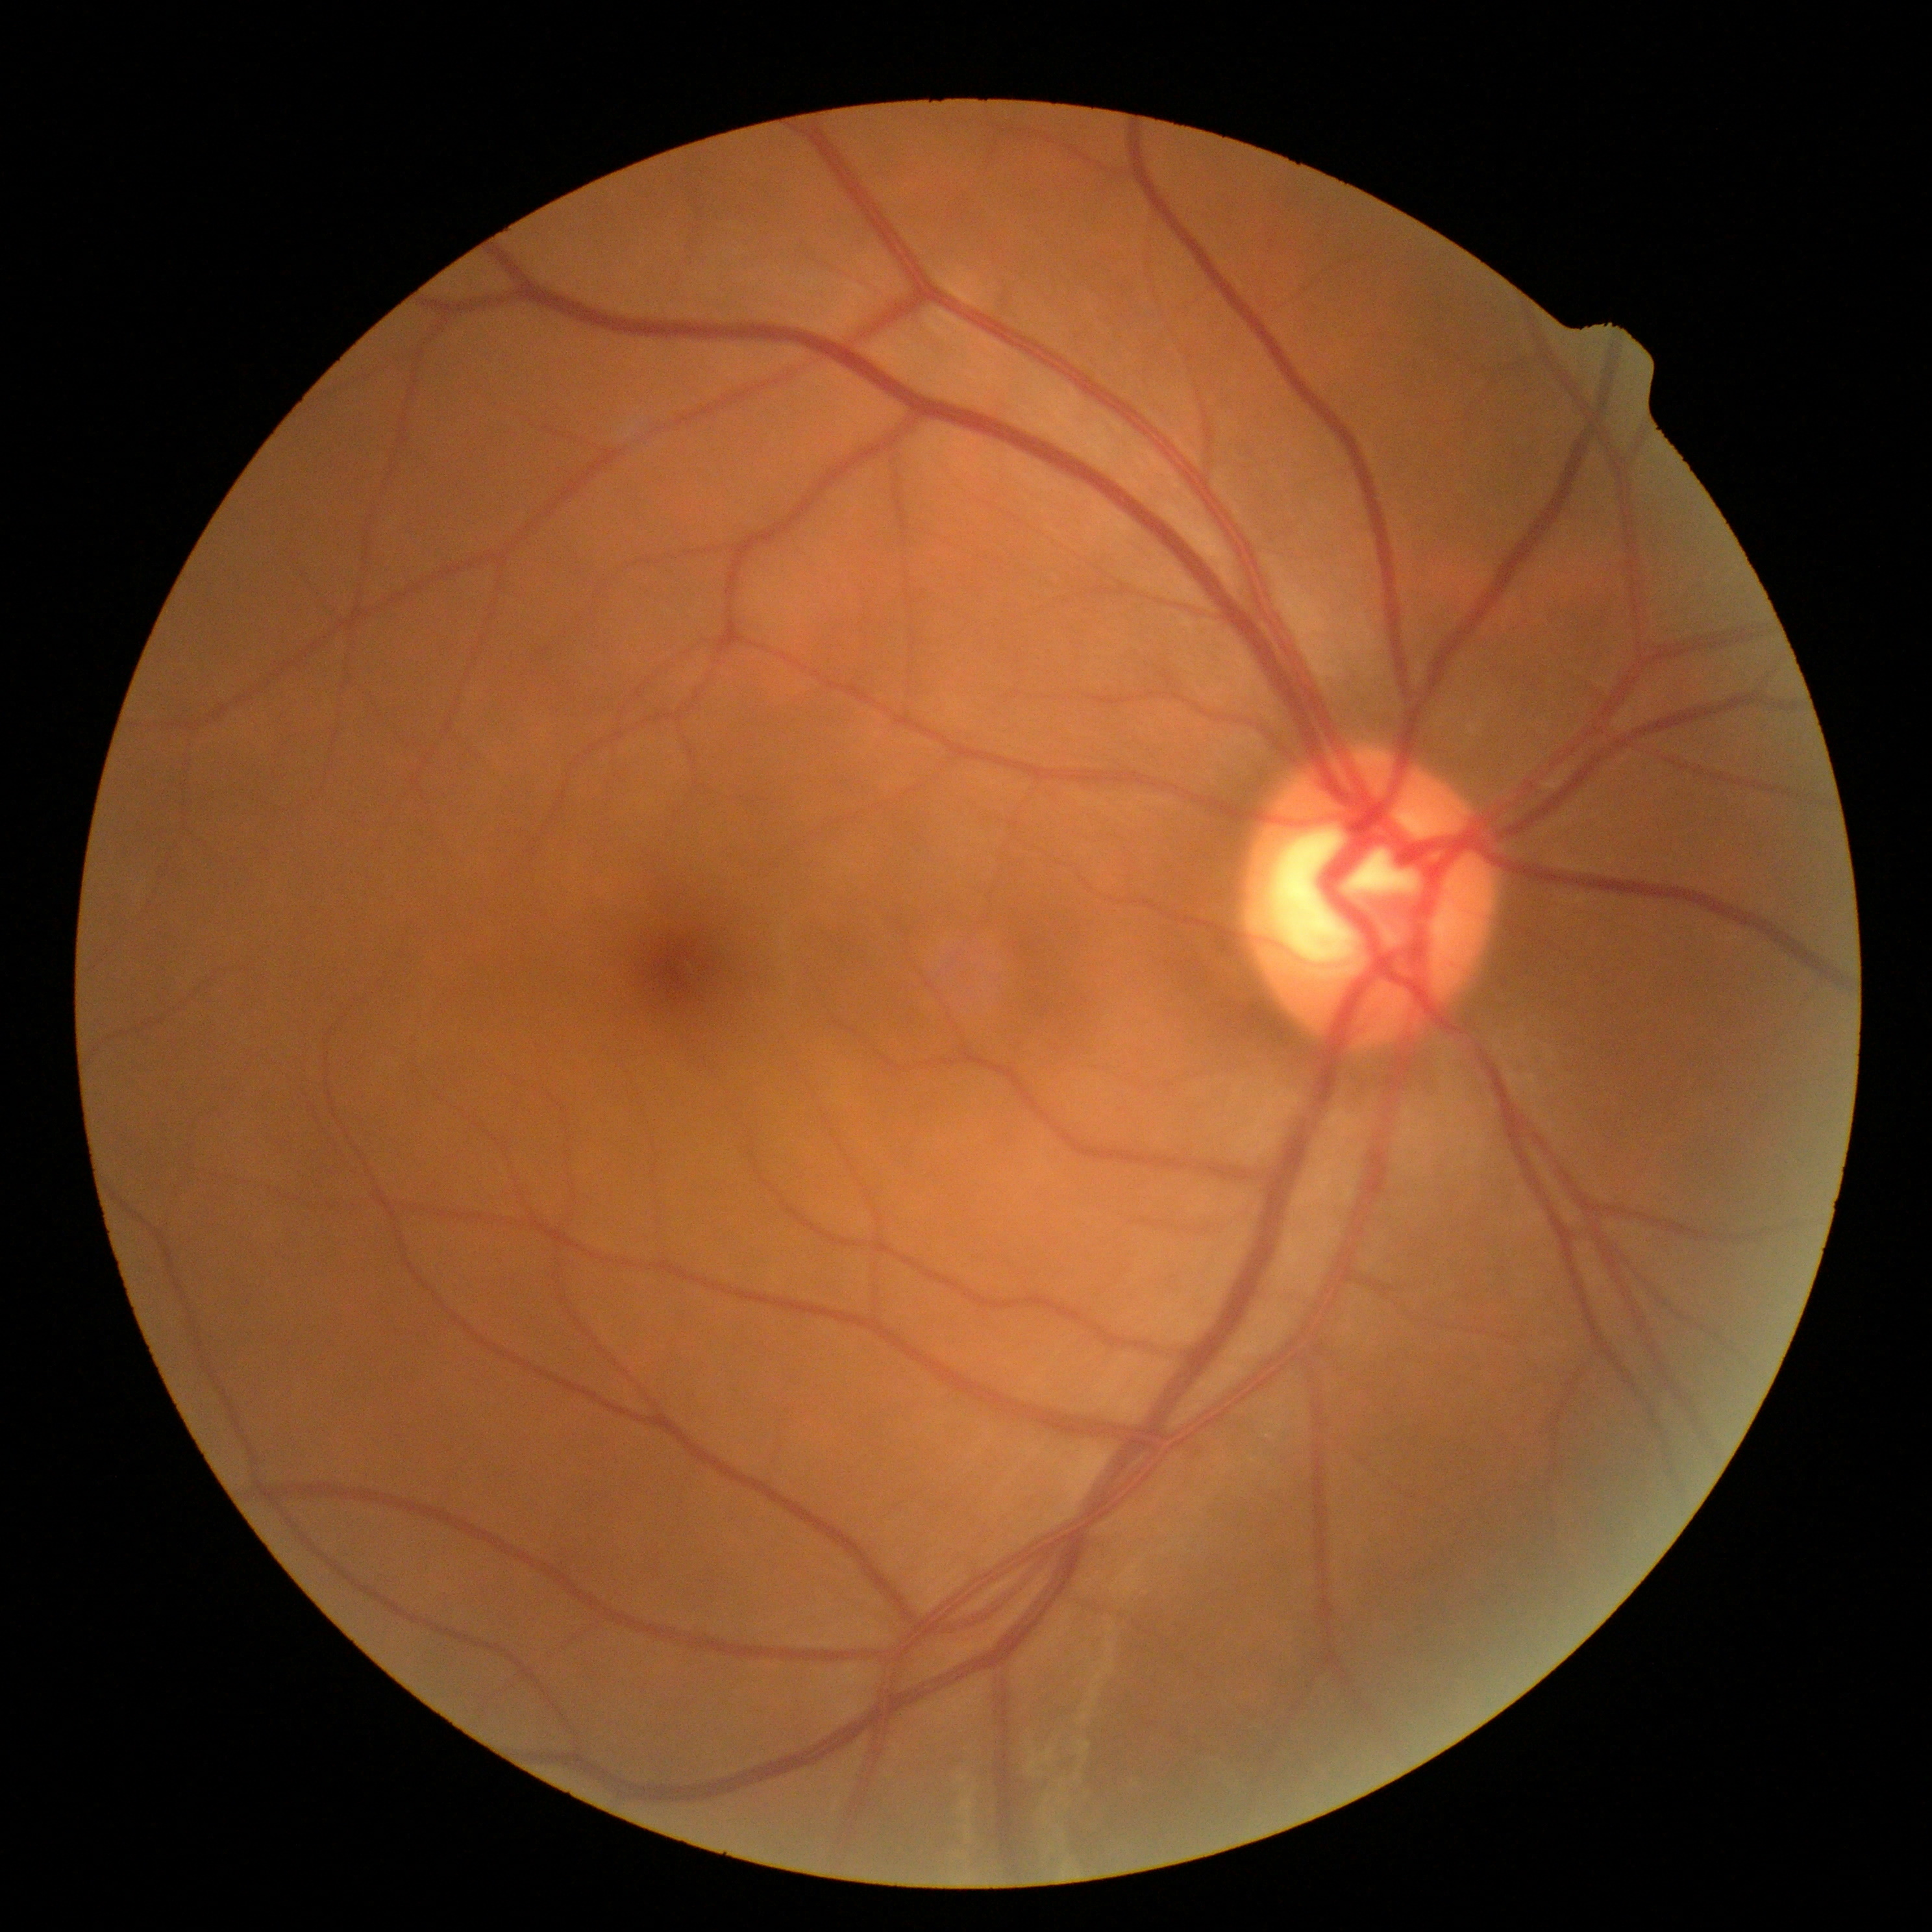
Diabetic retinopathy grade: 0 (no apparent retinopathy).